Image size 412x310:
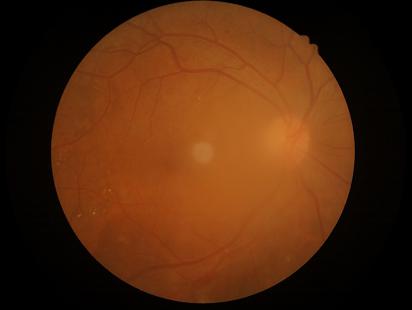 Quality assessment:
- sharpness: reduced sharpness with visible blur
- overall: poor and difficult to use diagnostically
- illumination: good illumination and color balance
- contrast: good dynamic range